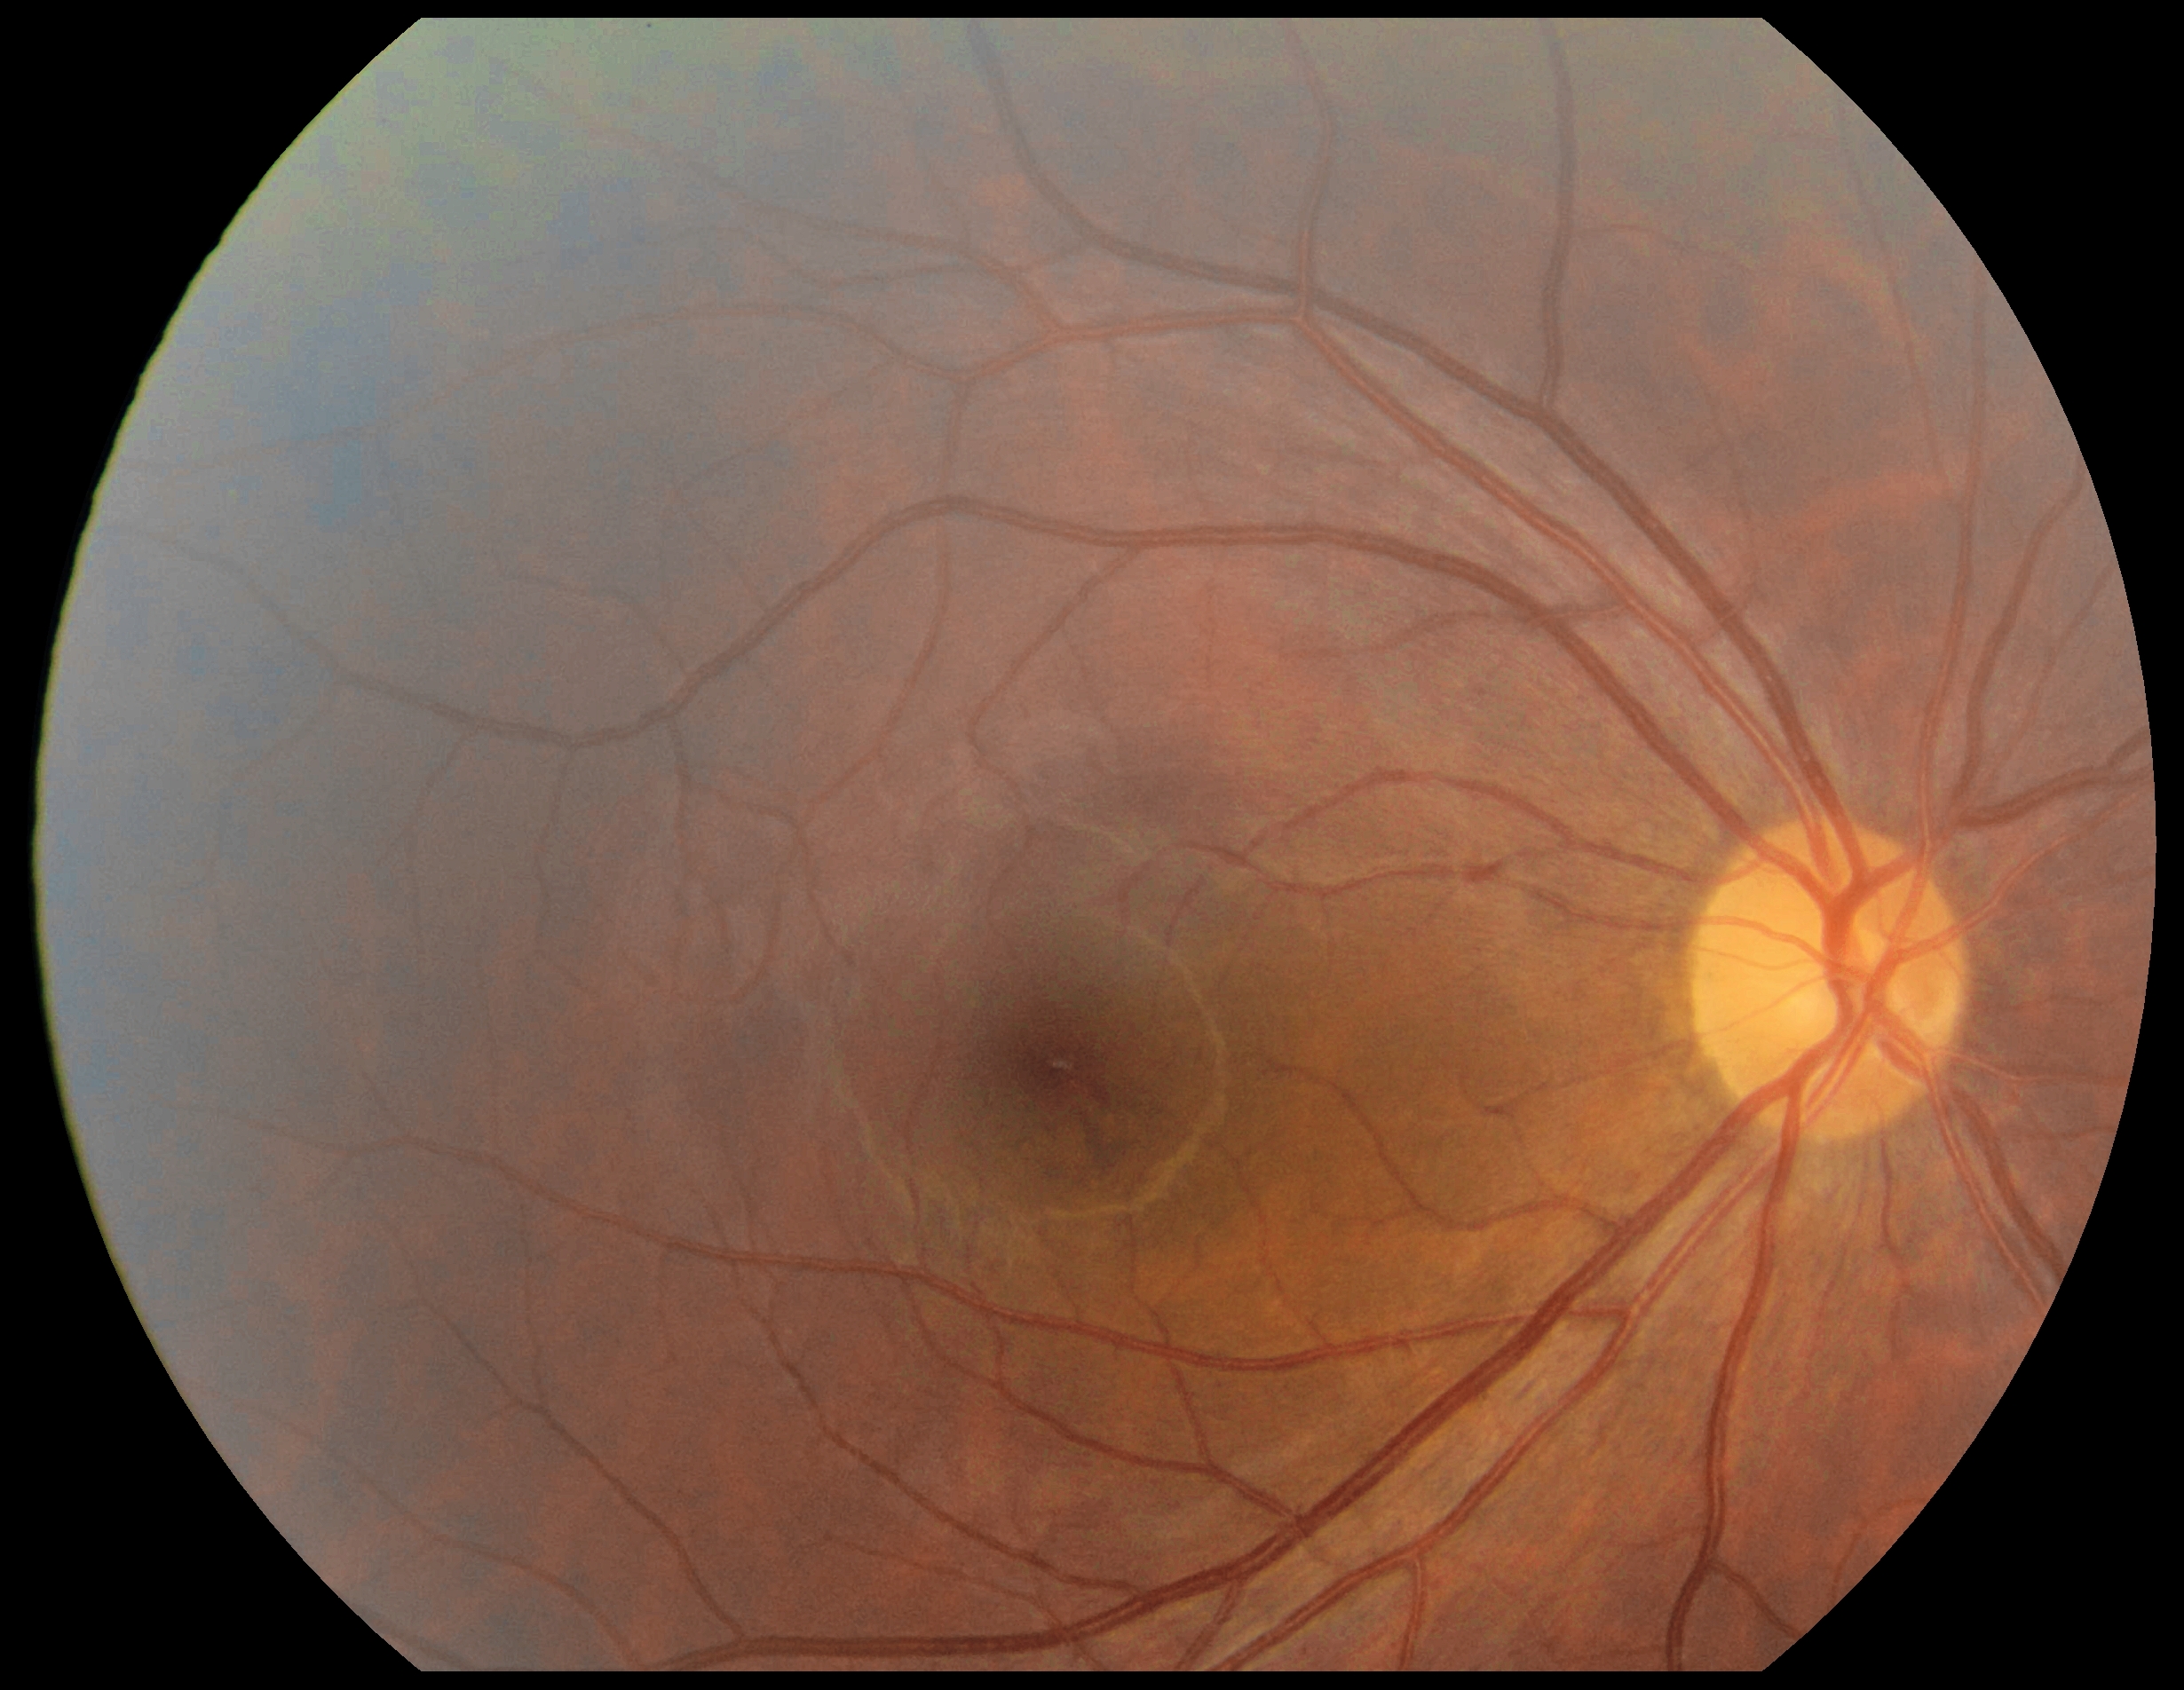

No DR findings. DR: 0/4.